RetCam wide-field infant fundus image
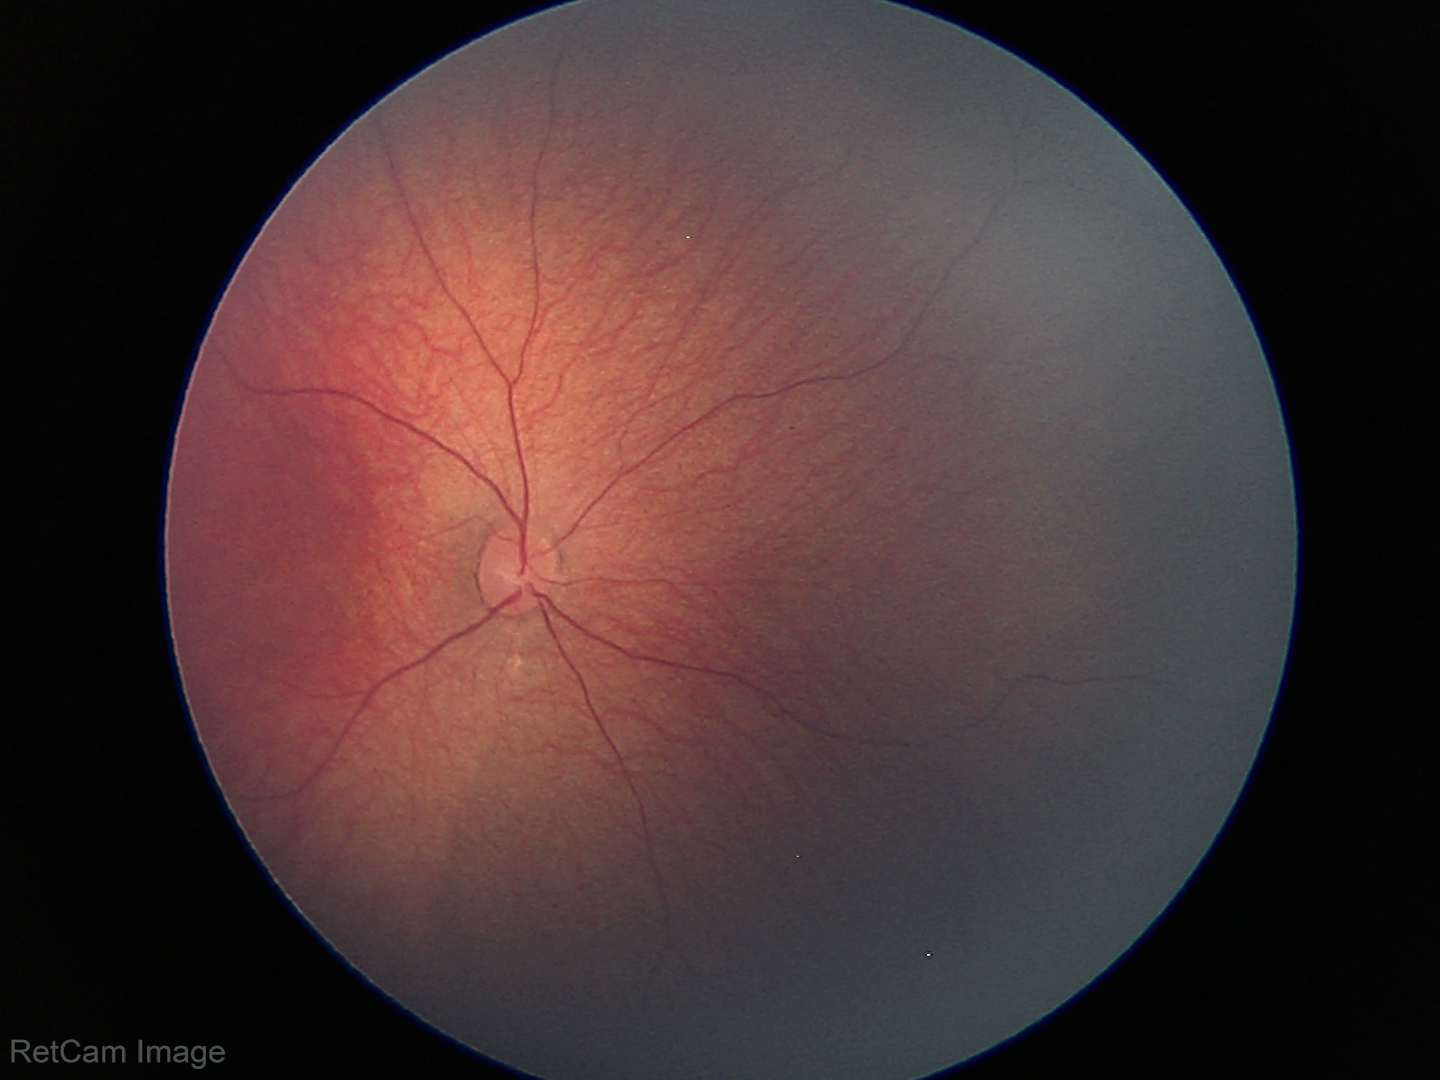 Impression = normal retinal appearance.